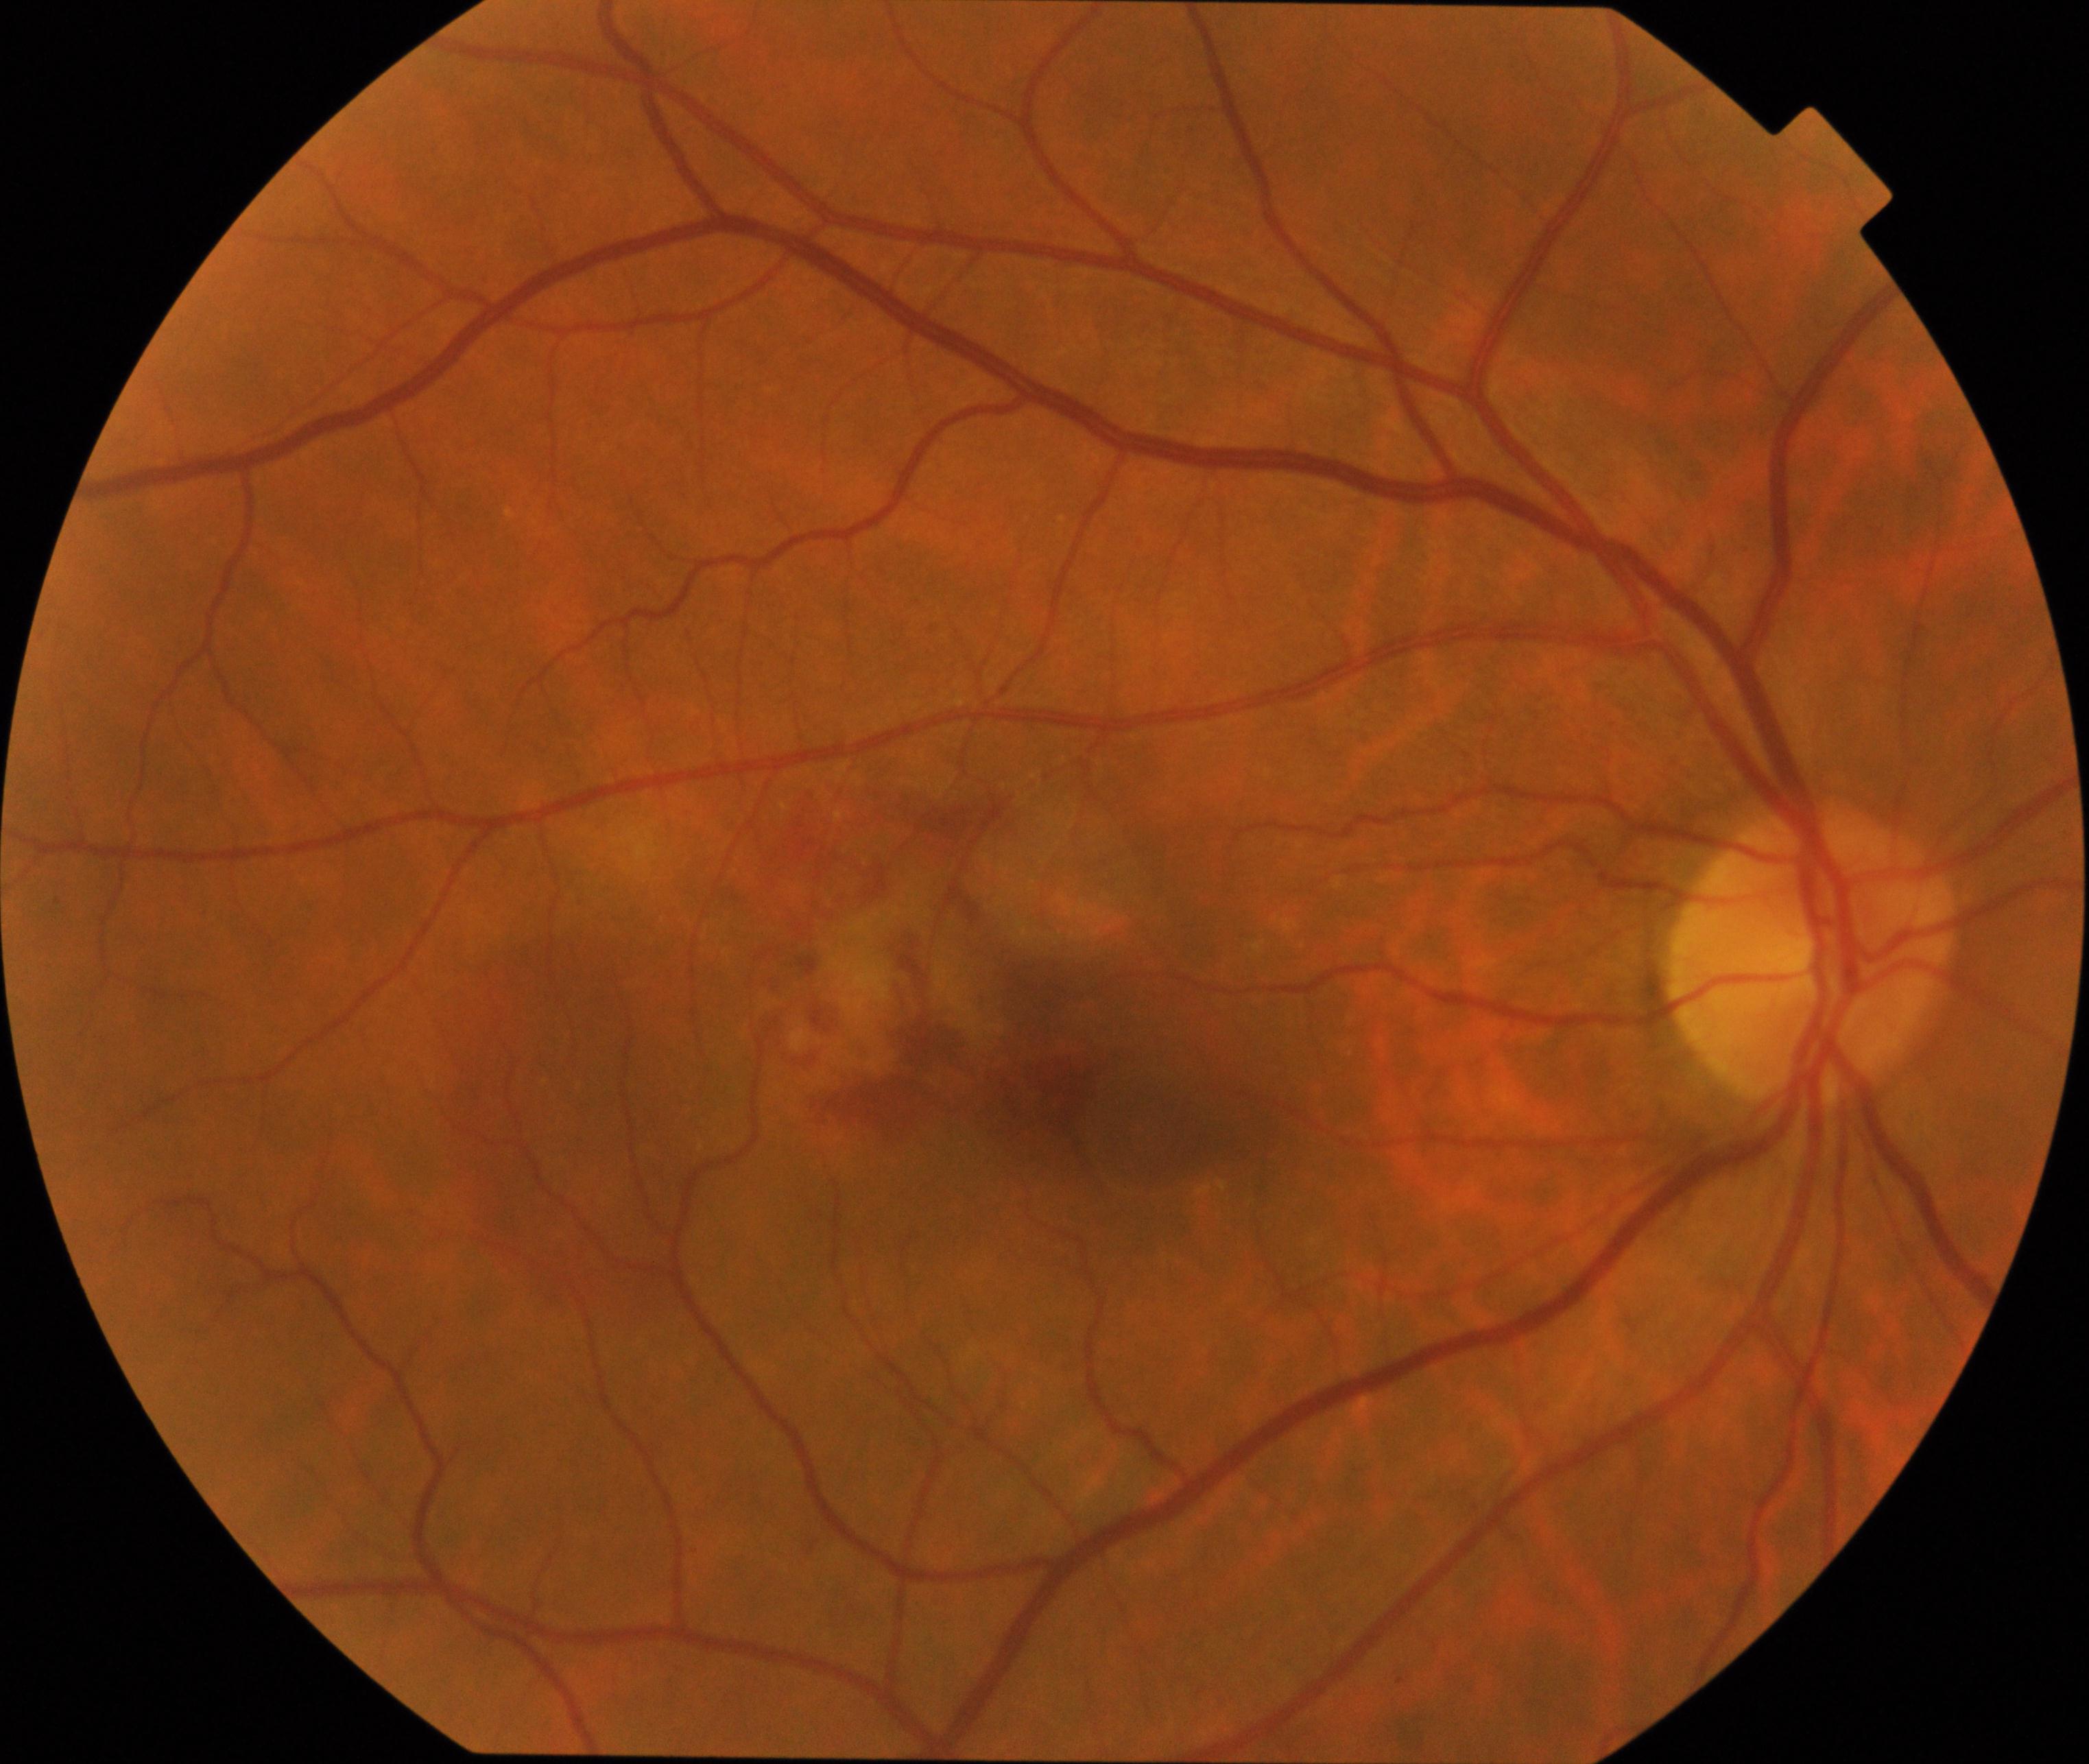

Findings: maculopathy.